45-degree field of view, image size 2352x1568, retinal fundus photograph:
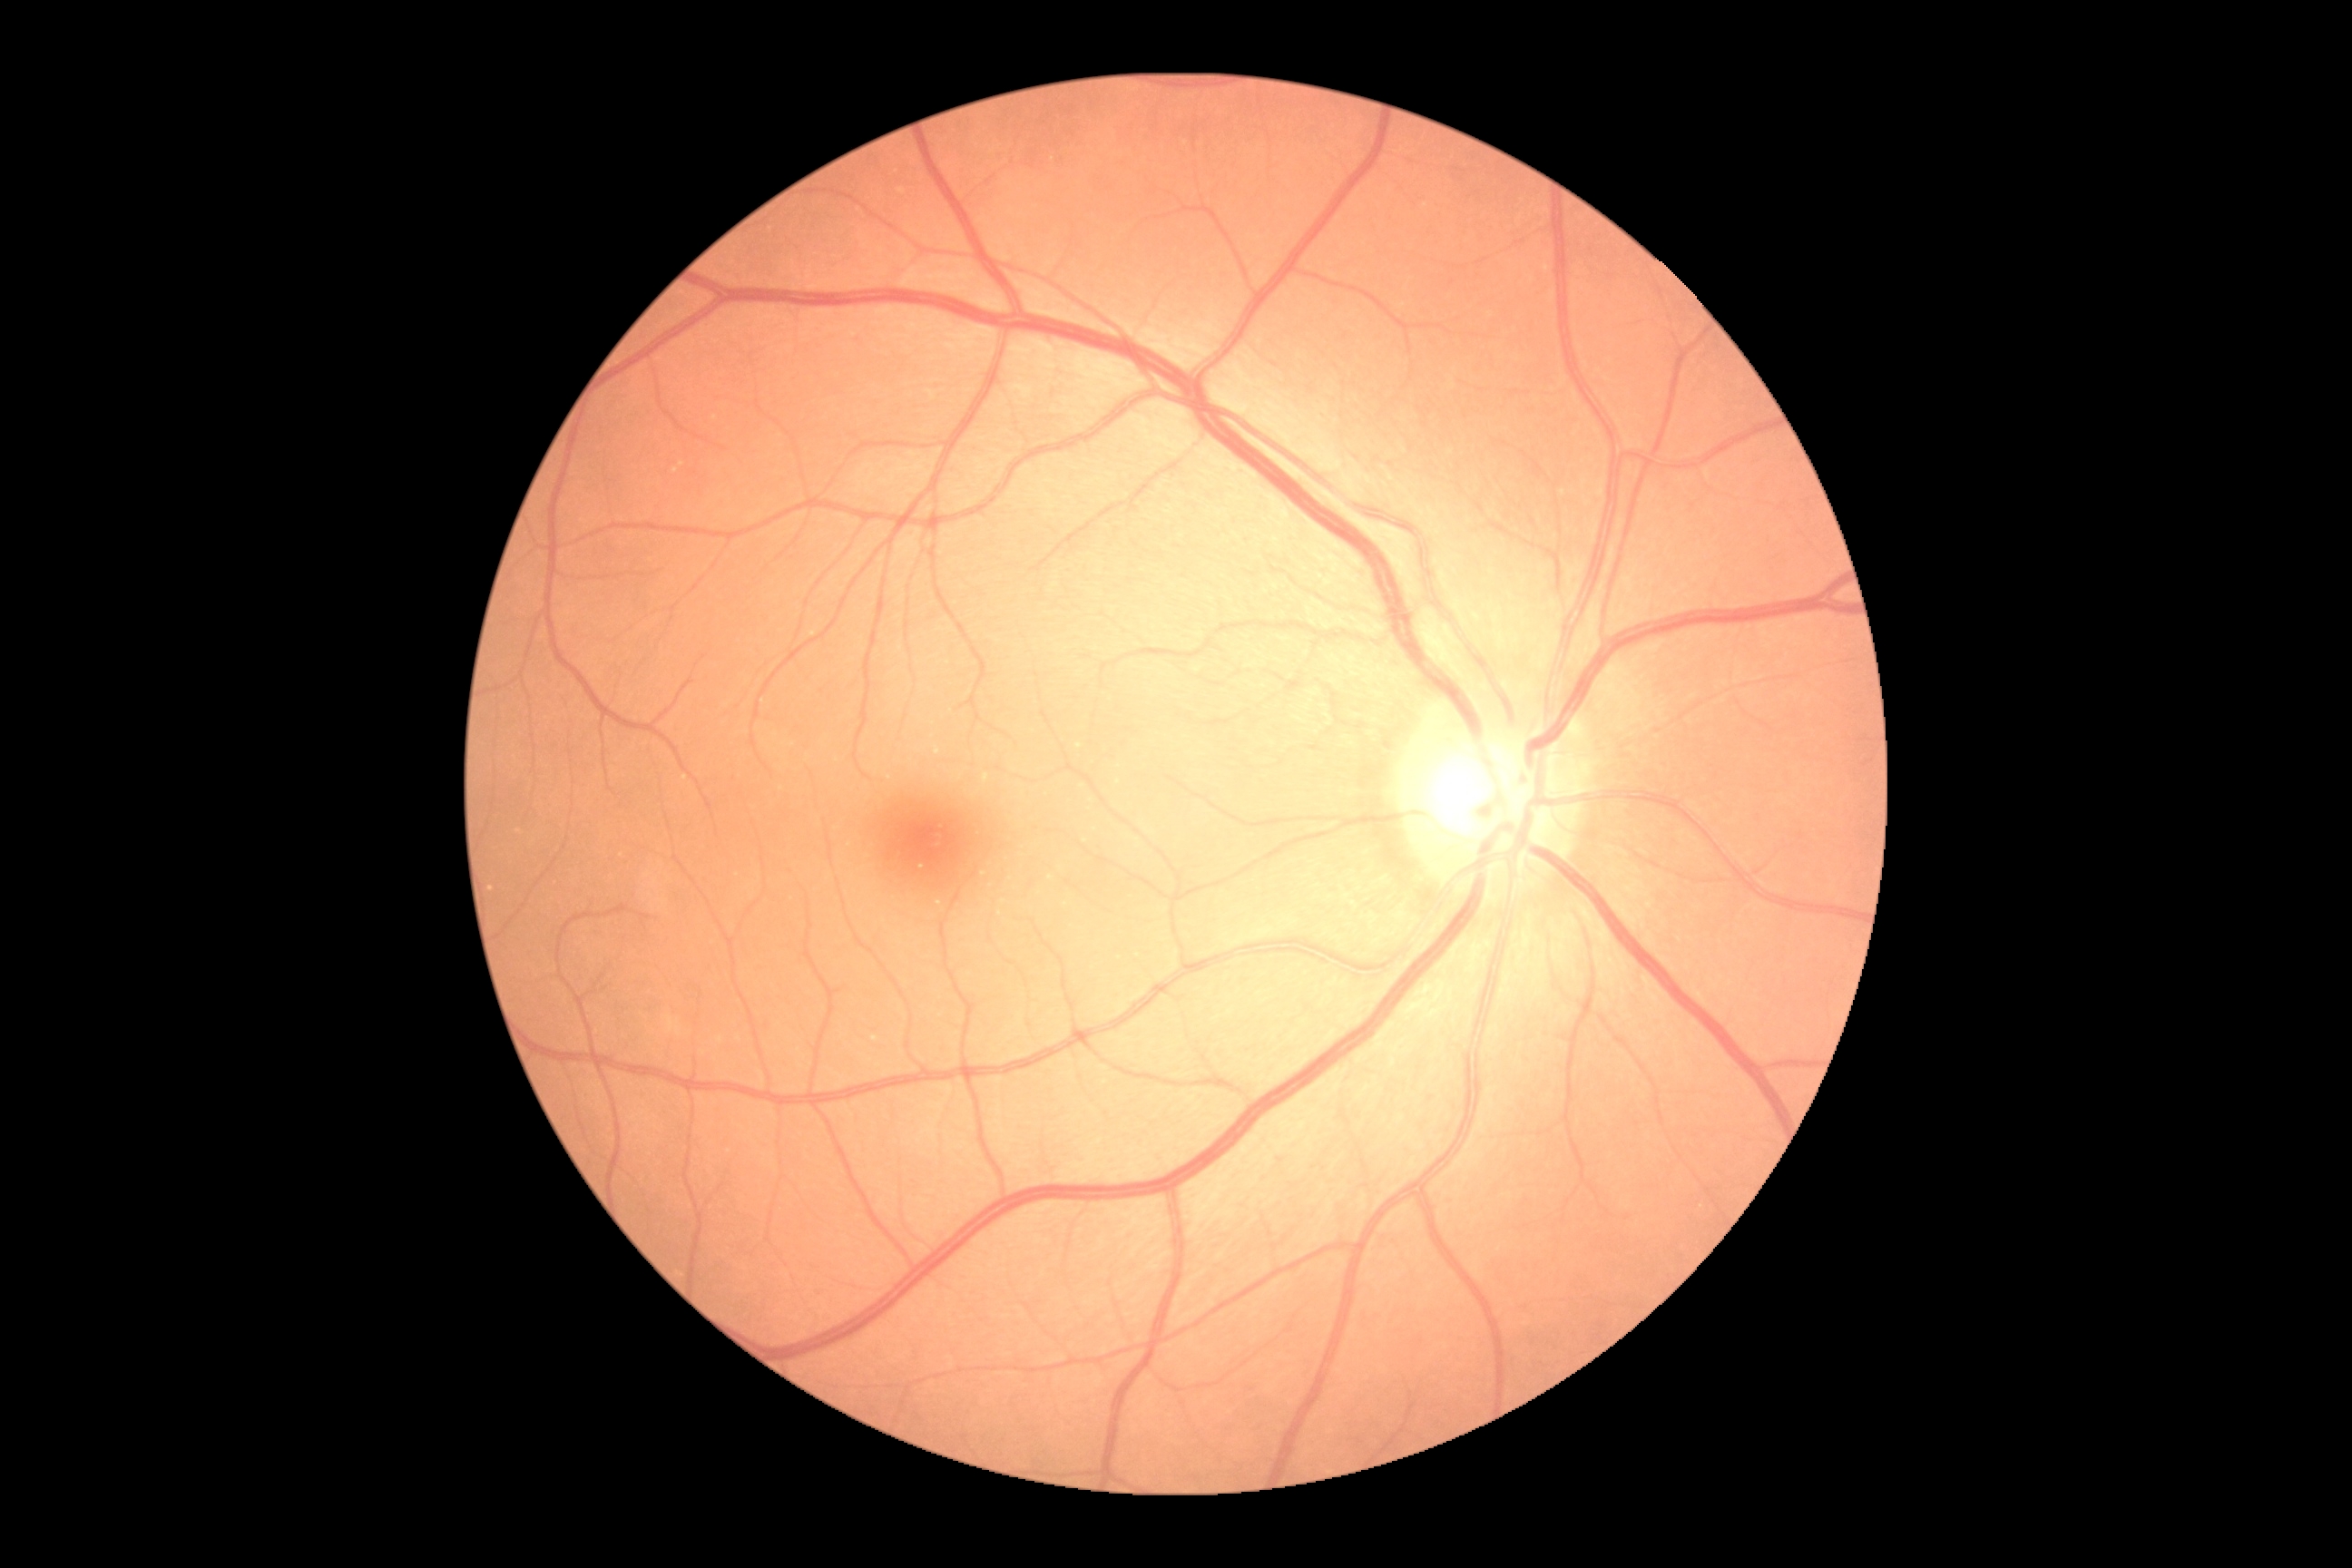

DR impression: no DR findings, diabetic retinopathy severity: 0/4.